Woman patient · axial length: 25.33 mm · CFP · IOP 20 mmHg · patient age: 65 years: 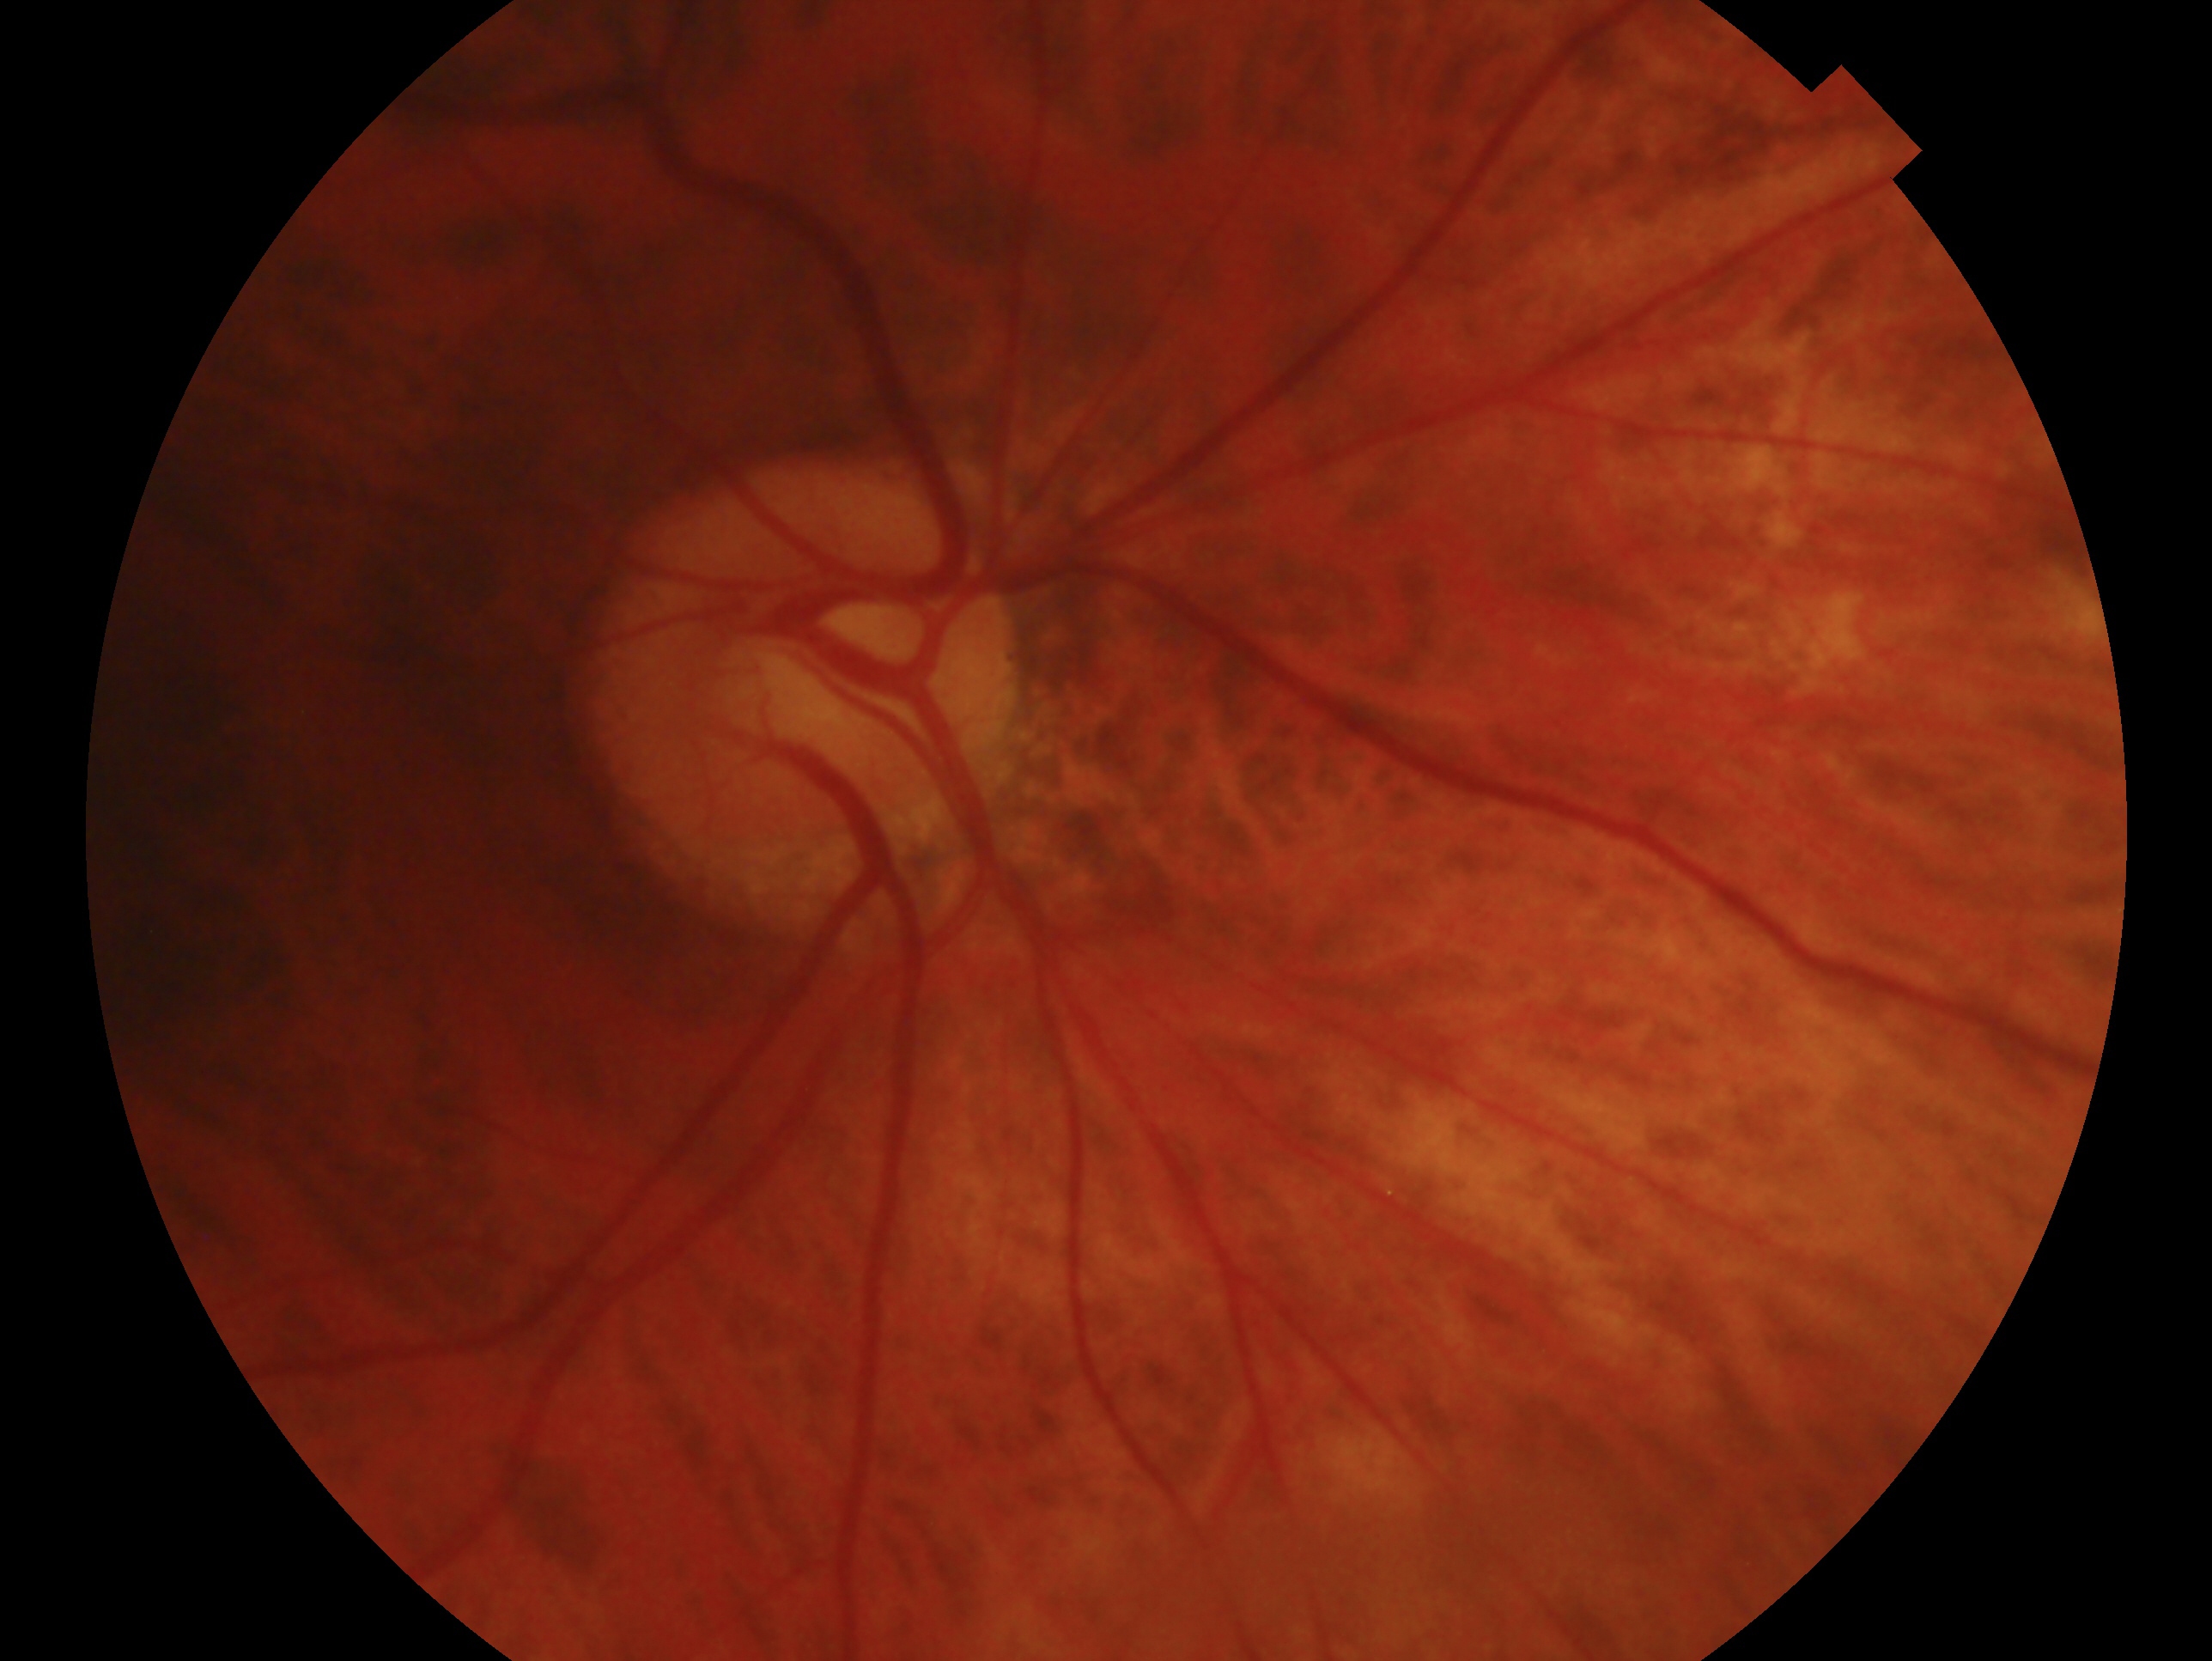

Glaucoma status — cannot be excluded.
Imaged eye: OD.